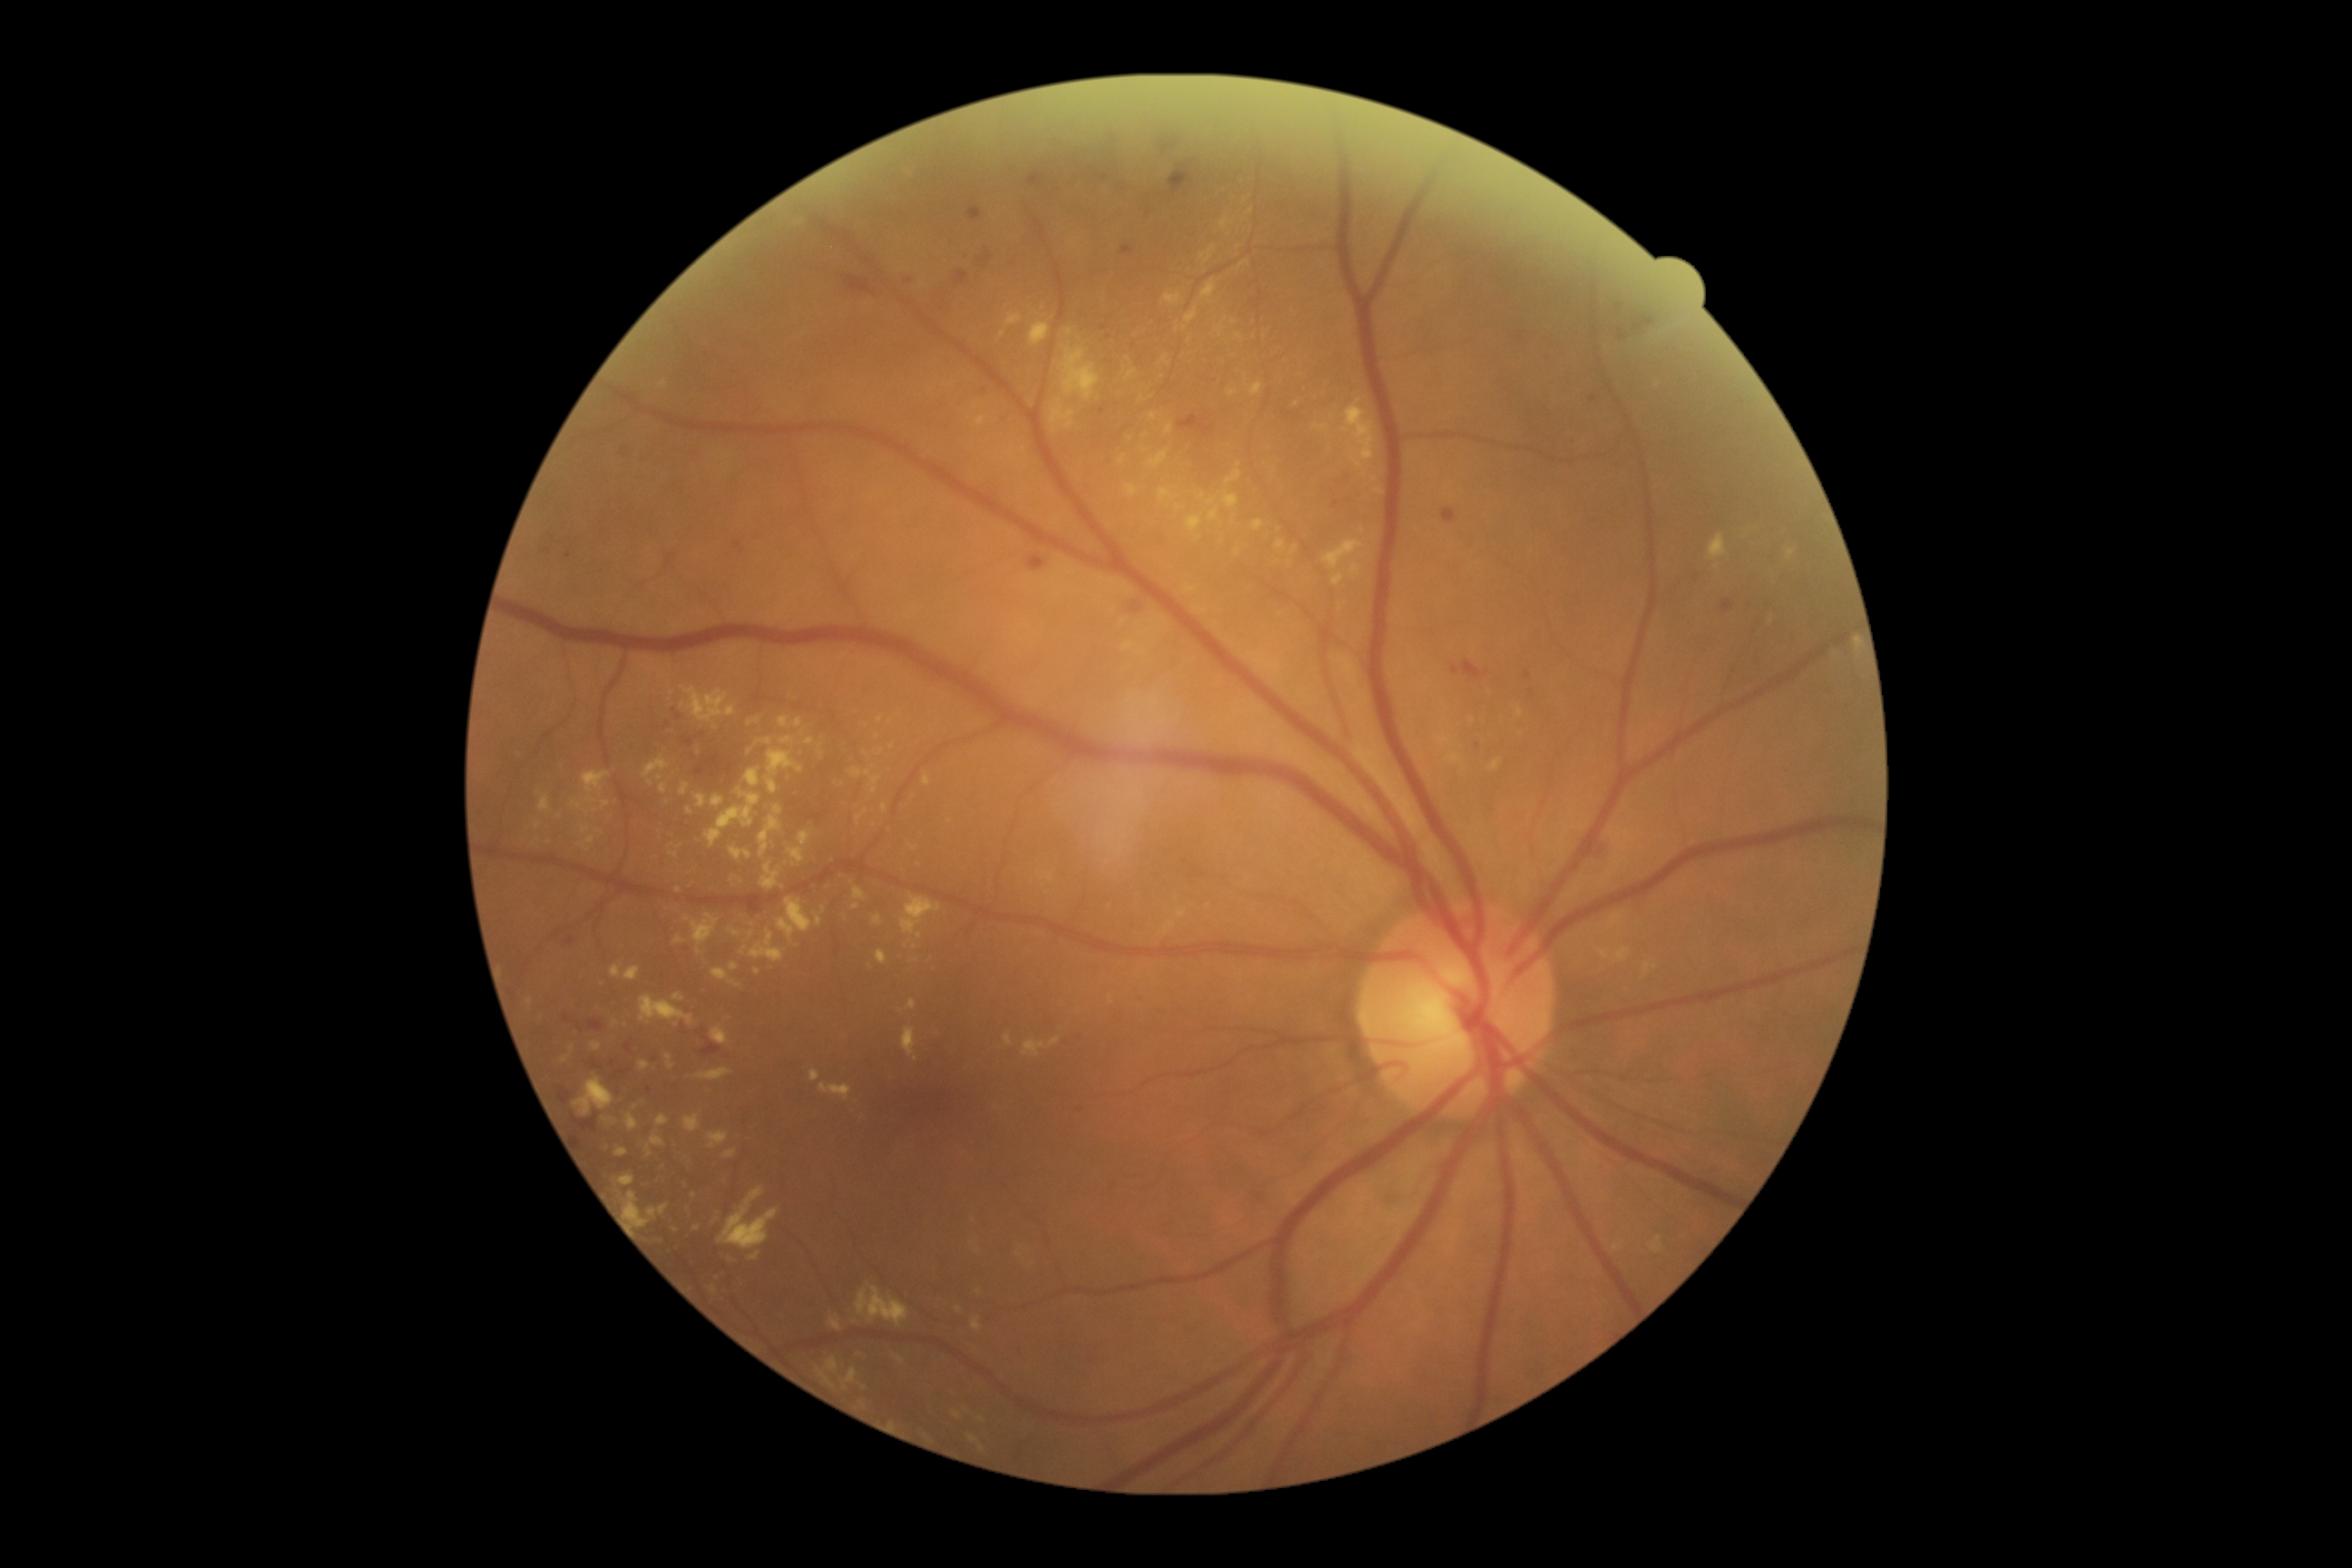

Diabetic retinopathy (DR): 2/4
Representative lesions:
* hard exudates (EXs) (partial): rect(1489, 760, 1502, 770), rect(923, 776, 930, 787), rect(1164, 293, 1182, 306), rect(1518, 707, 1524, 718), rect(1854, 638, 1861, 652), rect(1277, 540, 1286, 551), rect(761, 863, 779, 890), rect(1322, 540, 1366, 571), rect(730, 848, 752, 861), rect(876, 950, 888, 965), rect(847, 1369, 858, 1384)
* Additional small EXs near {"x": 979, "y": 1292}, {"x": 1368, "y": 497}, {"x": 530, "y": 1002}, {"x": 716, "y": 728}, {"x": 1177, "y": 329}, {"x": 693, "y": 1196}, {"x": 1374, "y": 481}